2212 x 1659 pixels:
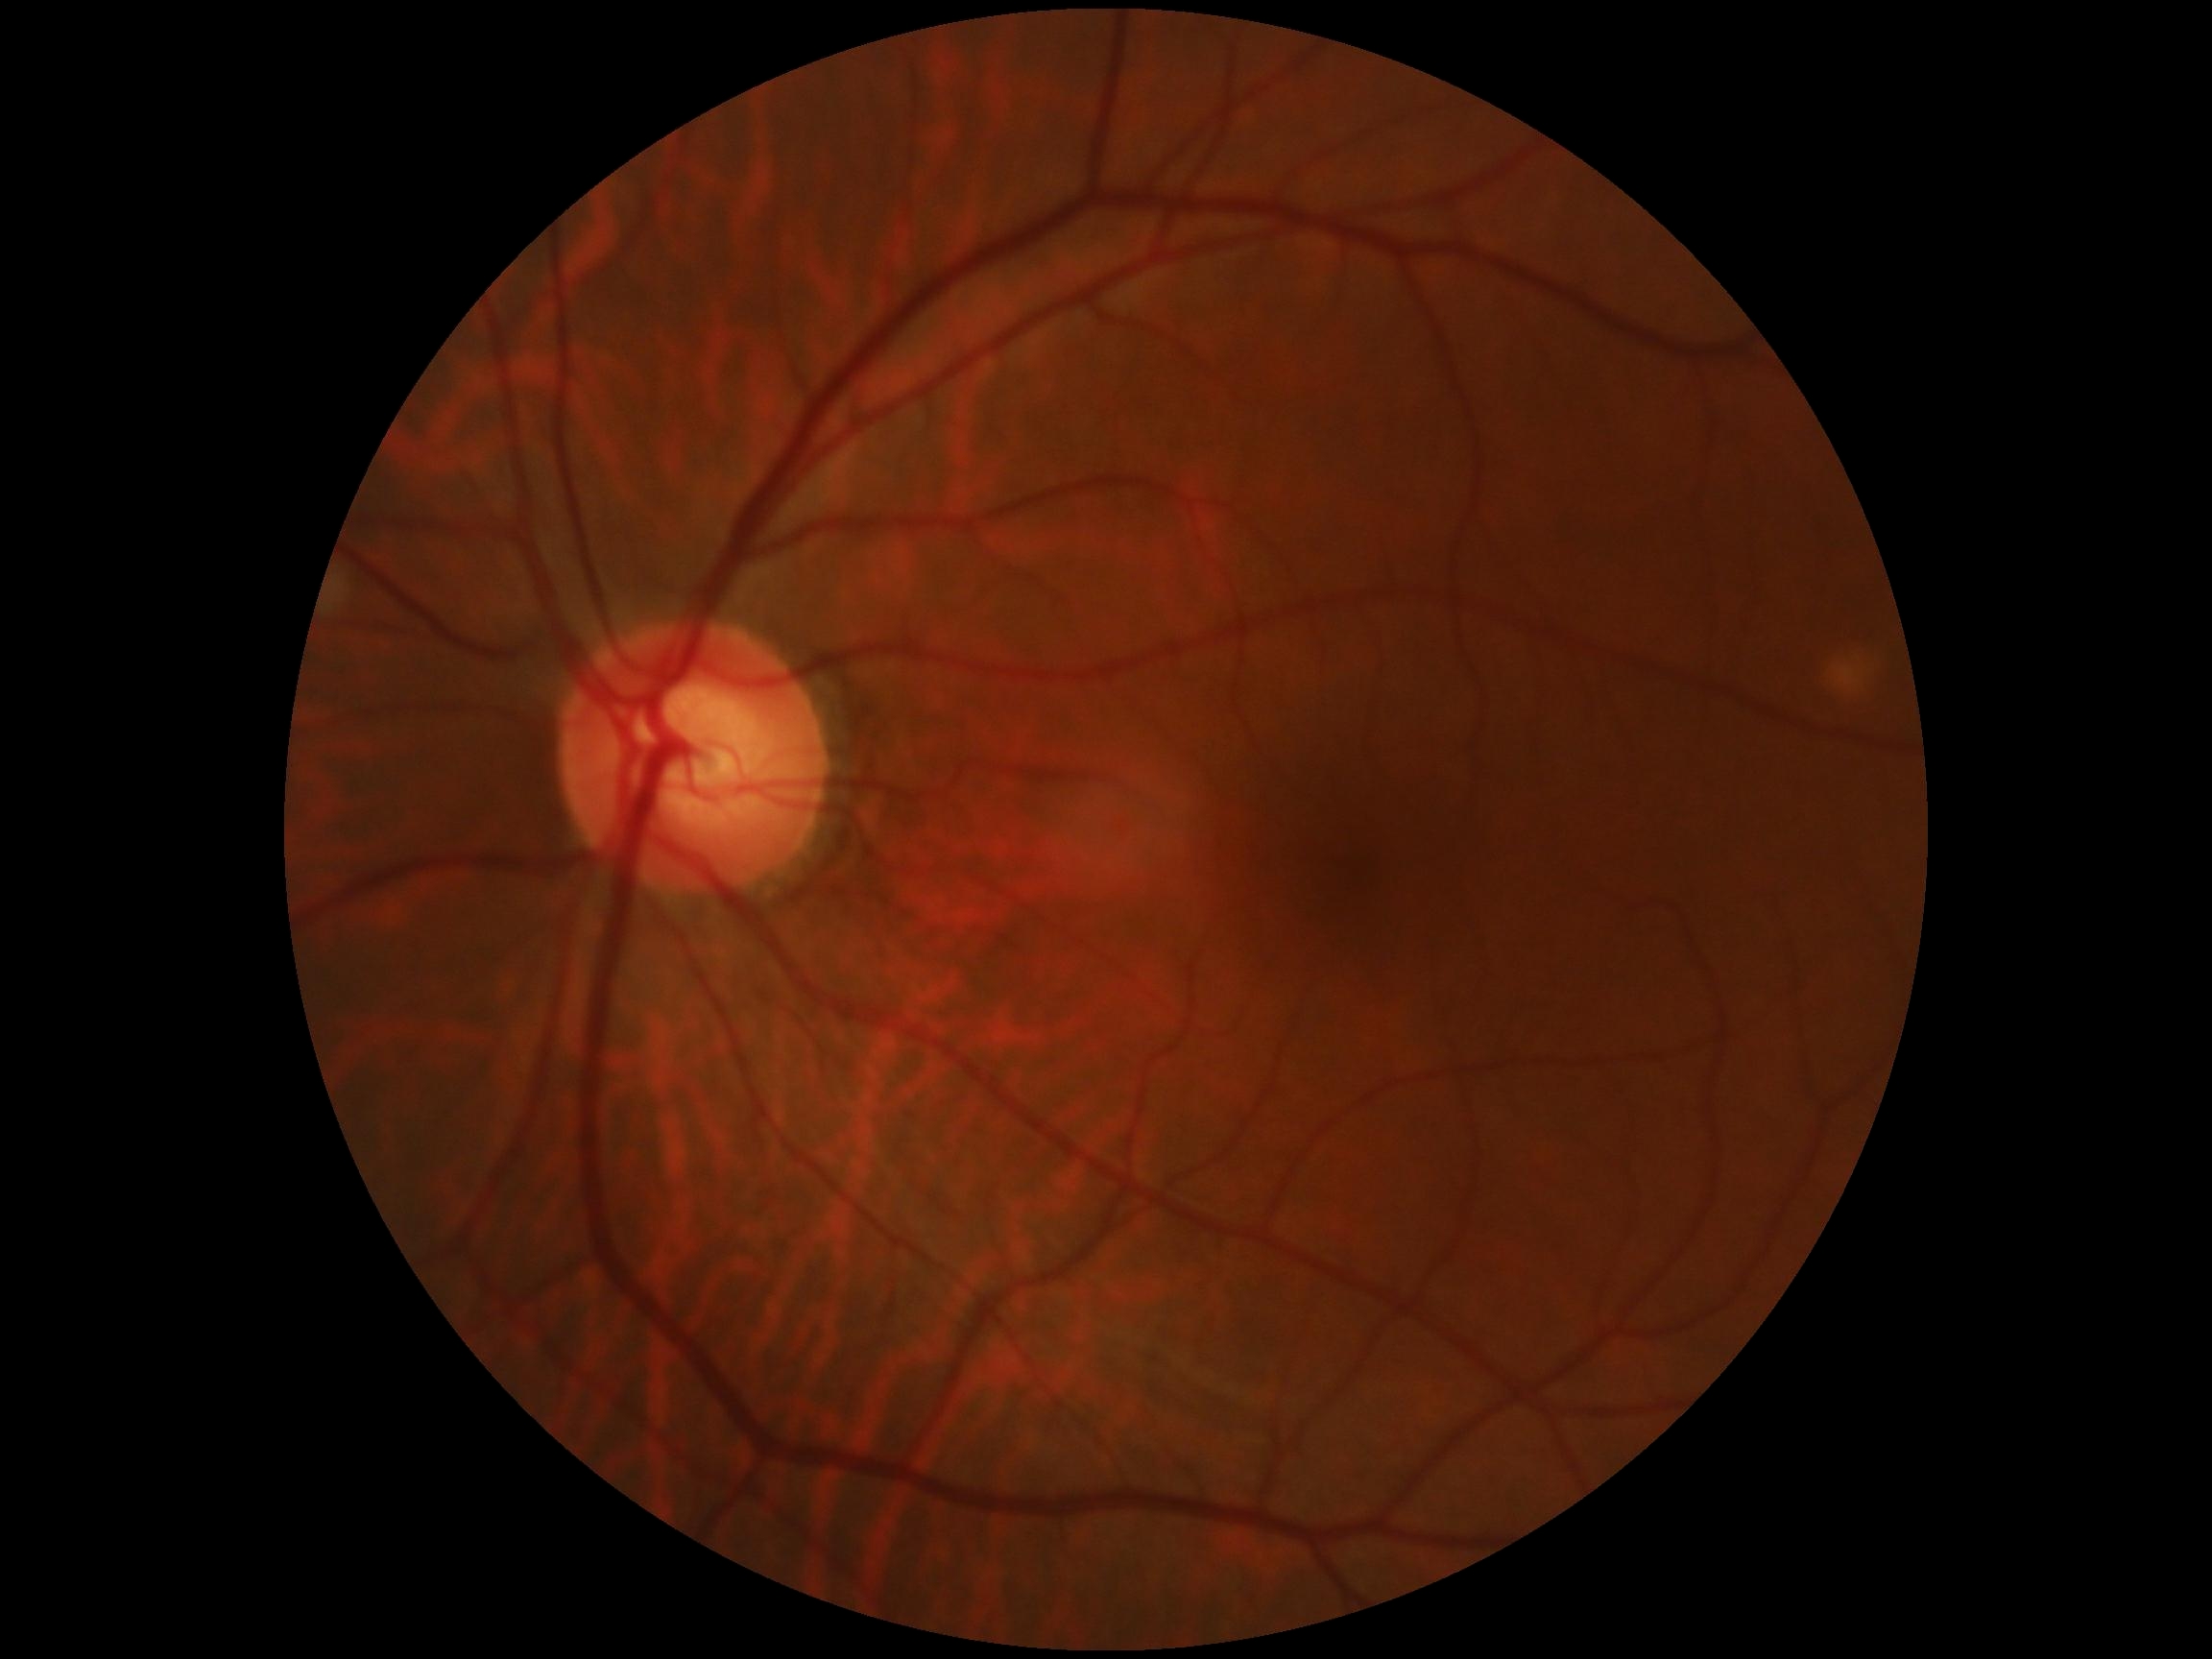 diabetic retinopathy grade: 0 | DR impression: no DR findings.